45-degree field of view; 2048x1536; retinal fundus photograph: 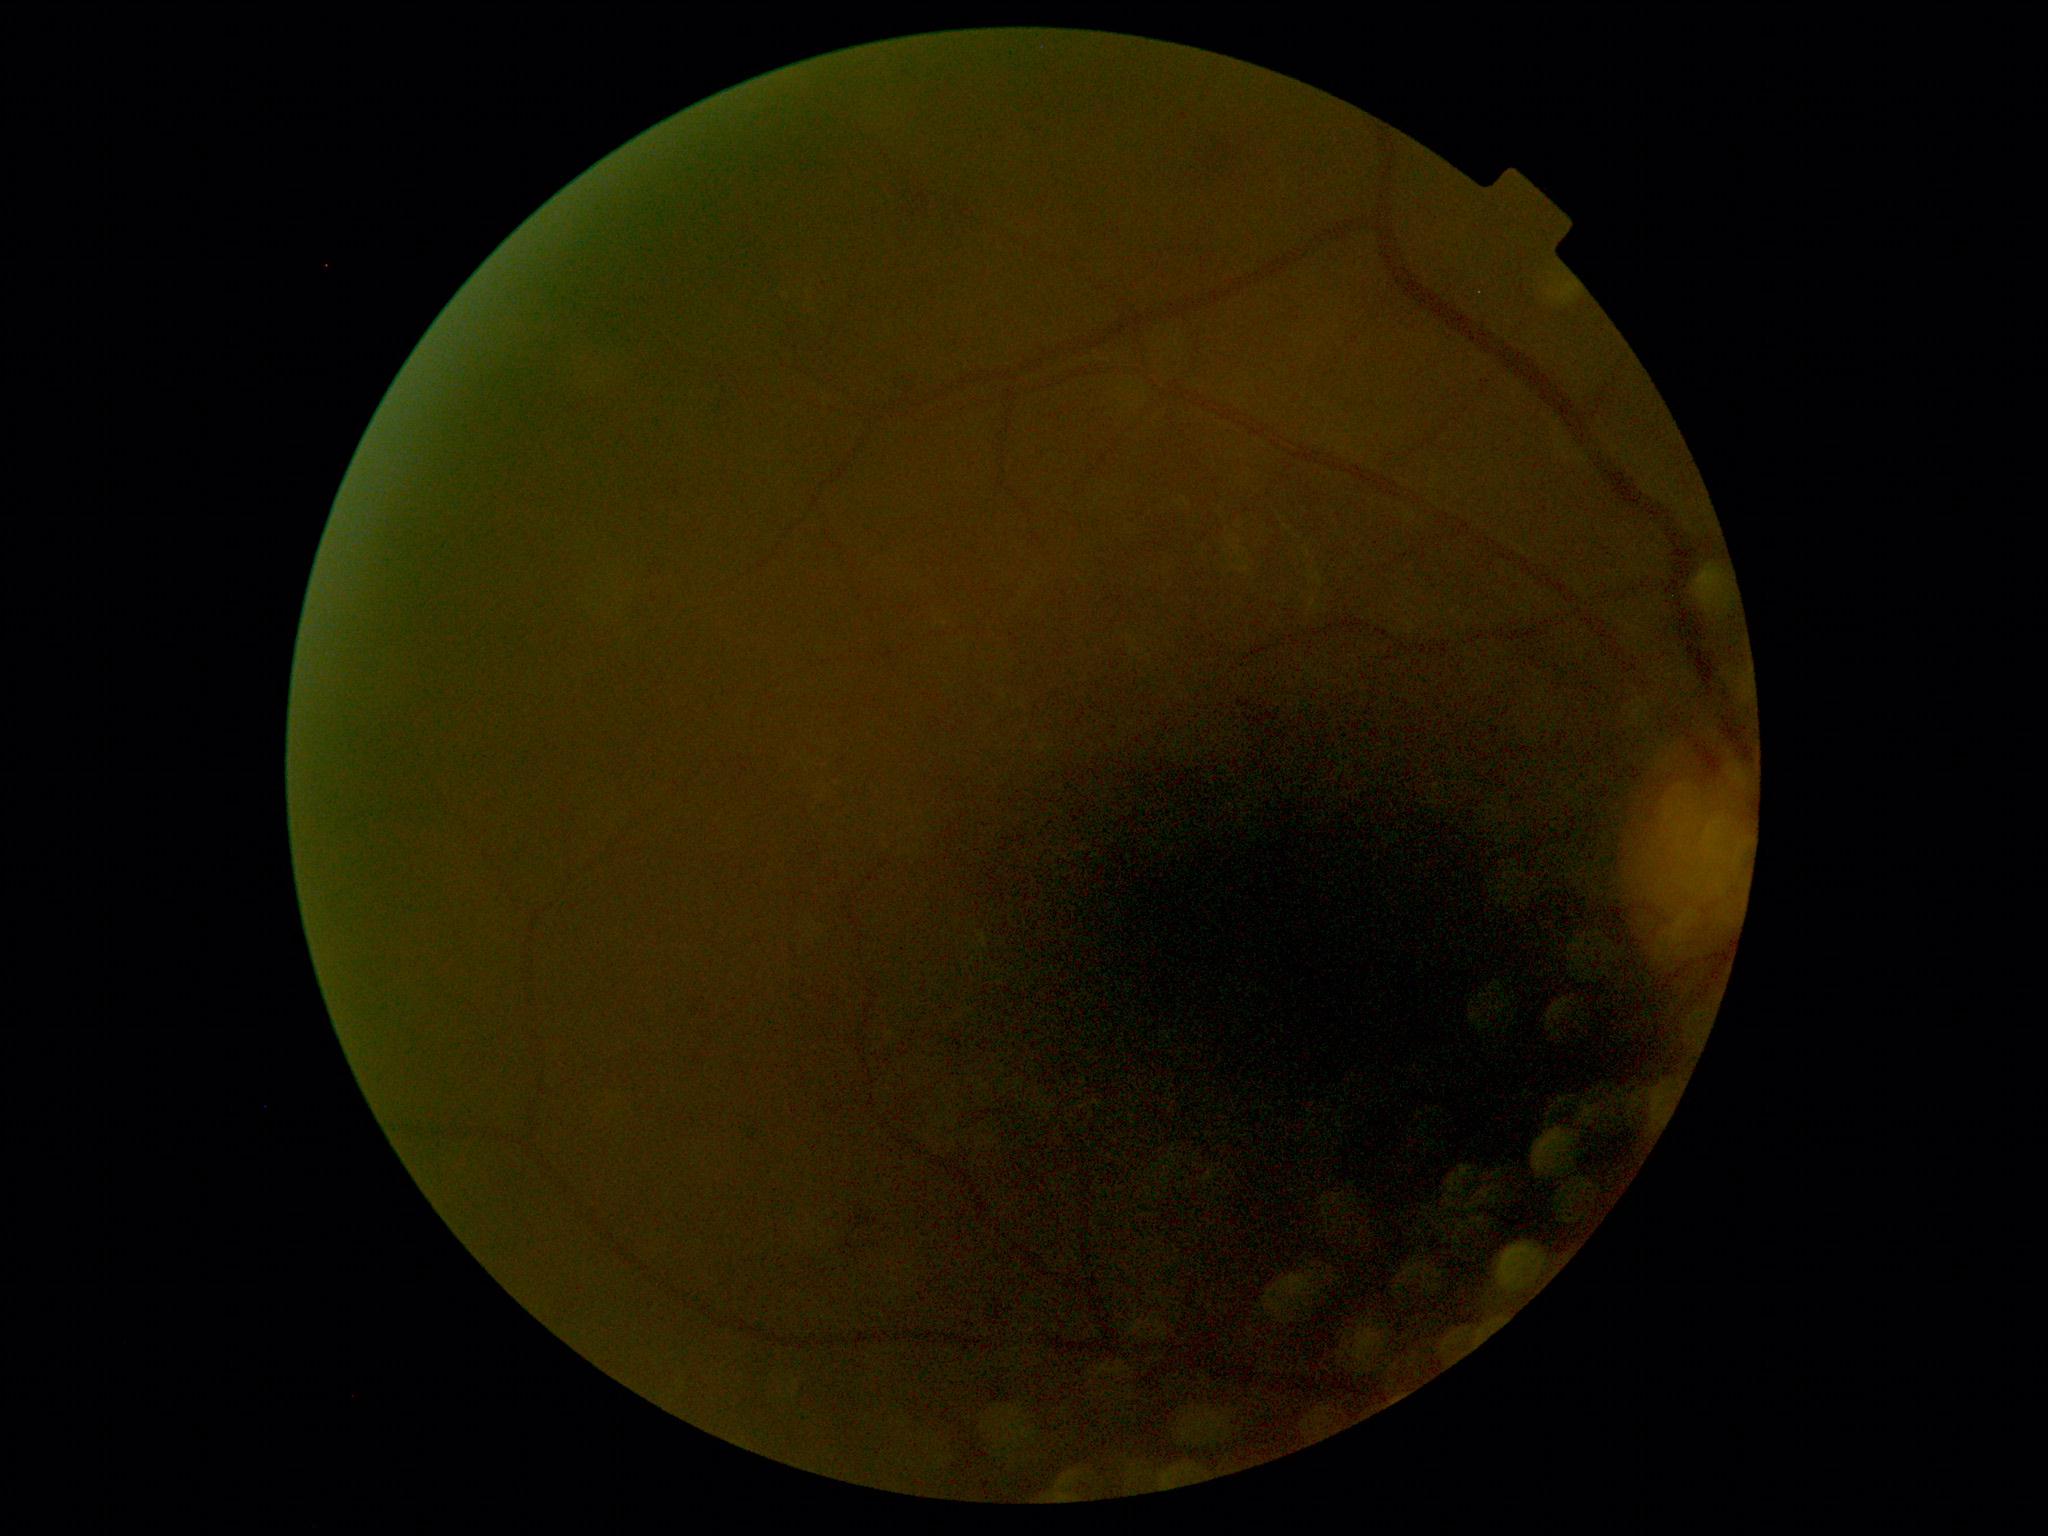 DR class: non-proliferative diabetic retinopathy, diabetic retinopathy grade: 2.